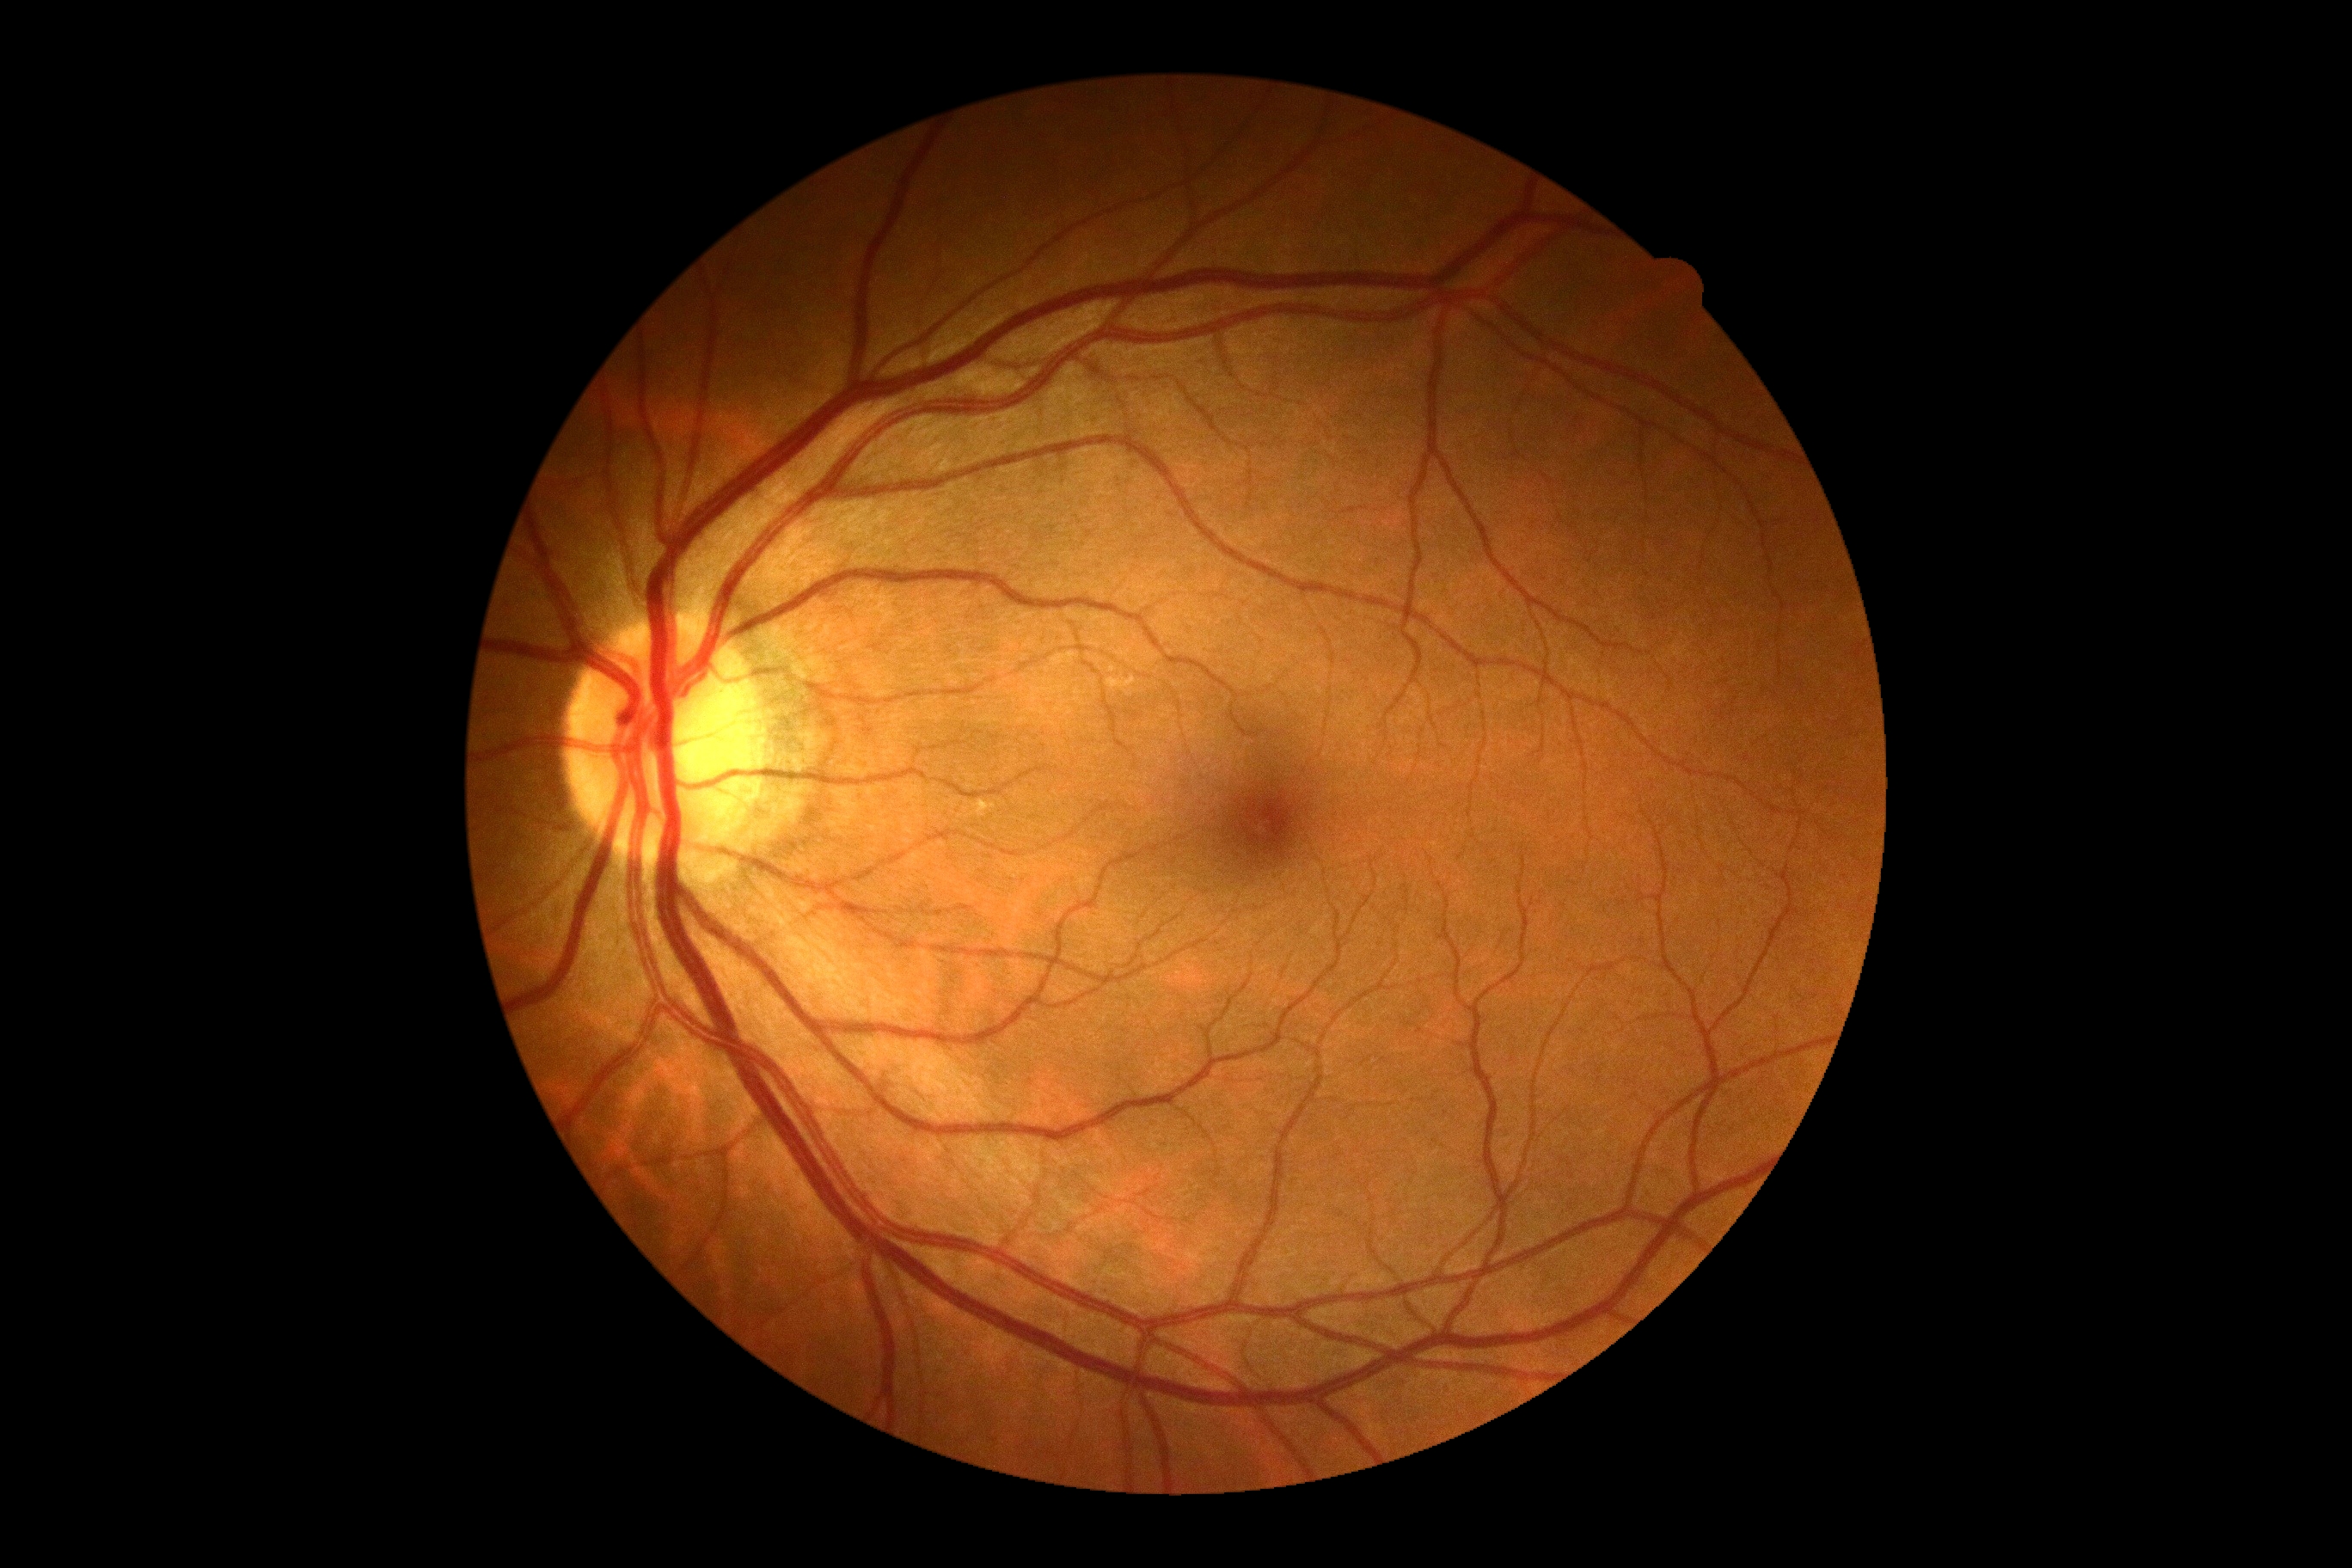 {
  "dr_impression": "negative for DR",
  "dr_grade": "no apparent retinopathy (grade 0)"
}